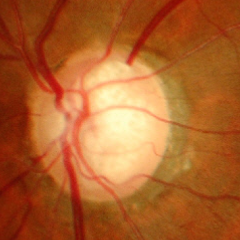

Glaucomatous changes are present.
Advanced glaucomatous optic neuropathy.